NIDEK AFC-230; without pupil dilation; color fundus photograph; DR severity per modified Davis staging; 45-degree field of view.
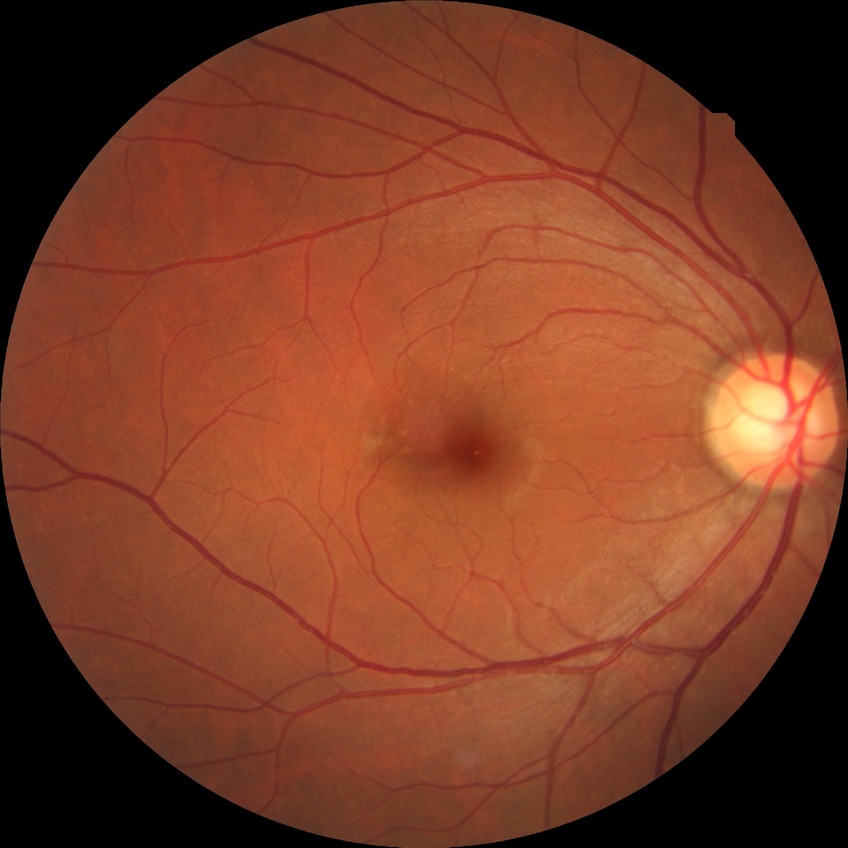
diabetic retinopathy (DR): NDR (no diabetic retinopathy).